Infant wide-field fundus photograph:
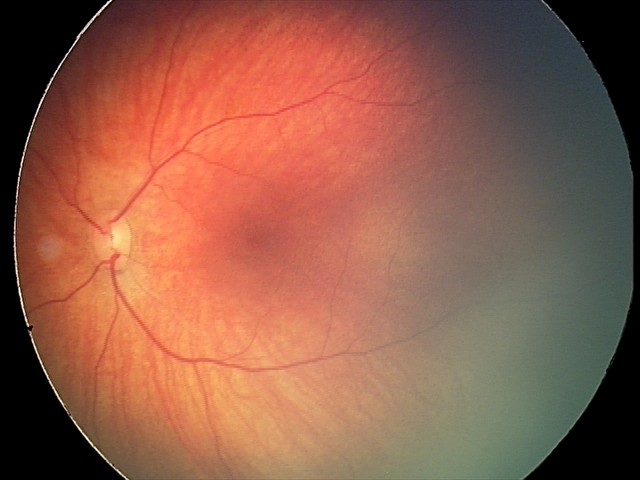
Screening series with retinal hemorrhages.